Retinal fundus photograph — 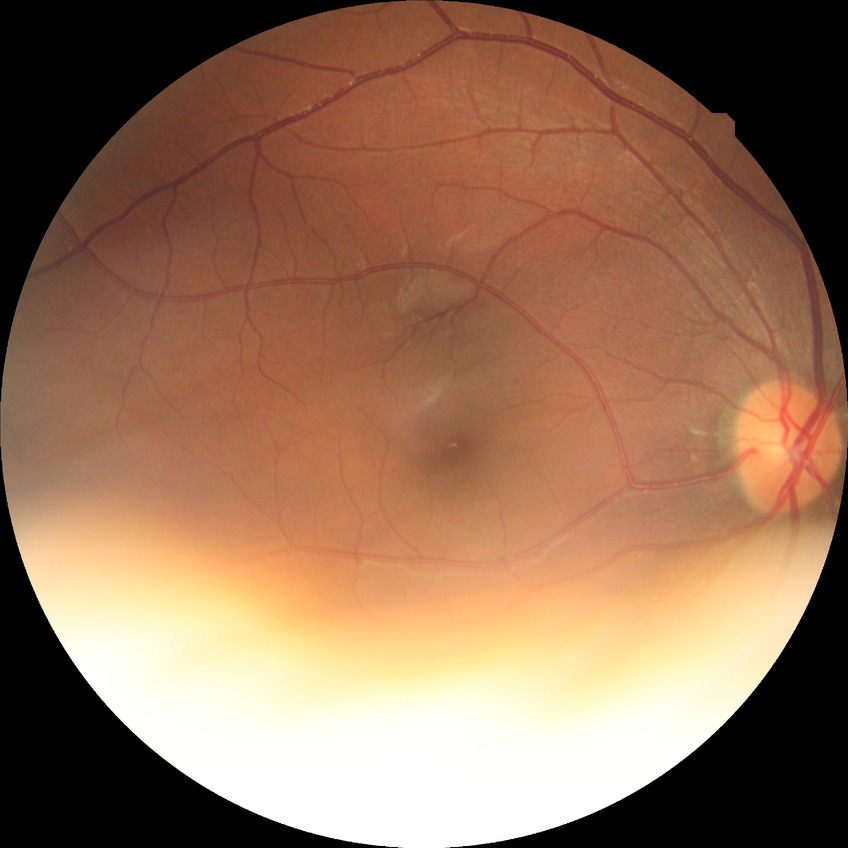 Diabetic retinopathy (DR): no diabetic retinopathy (NDR).